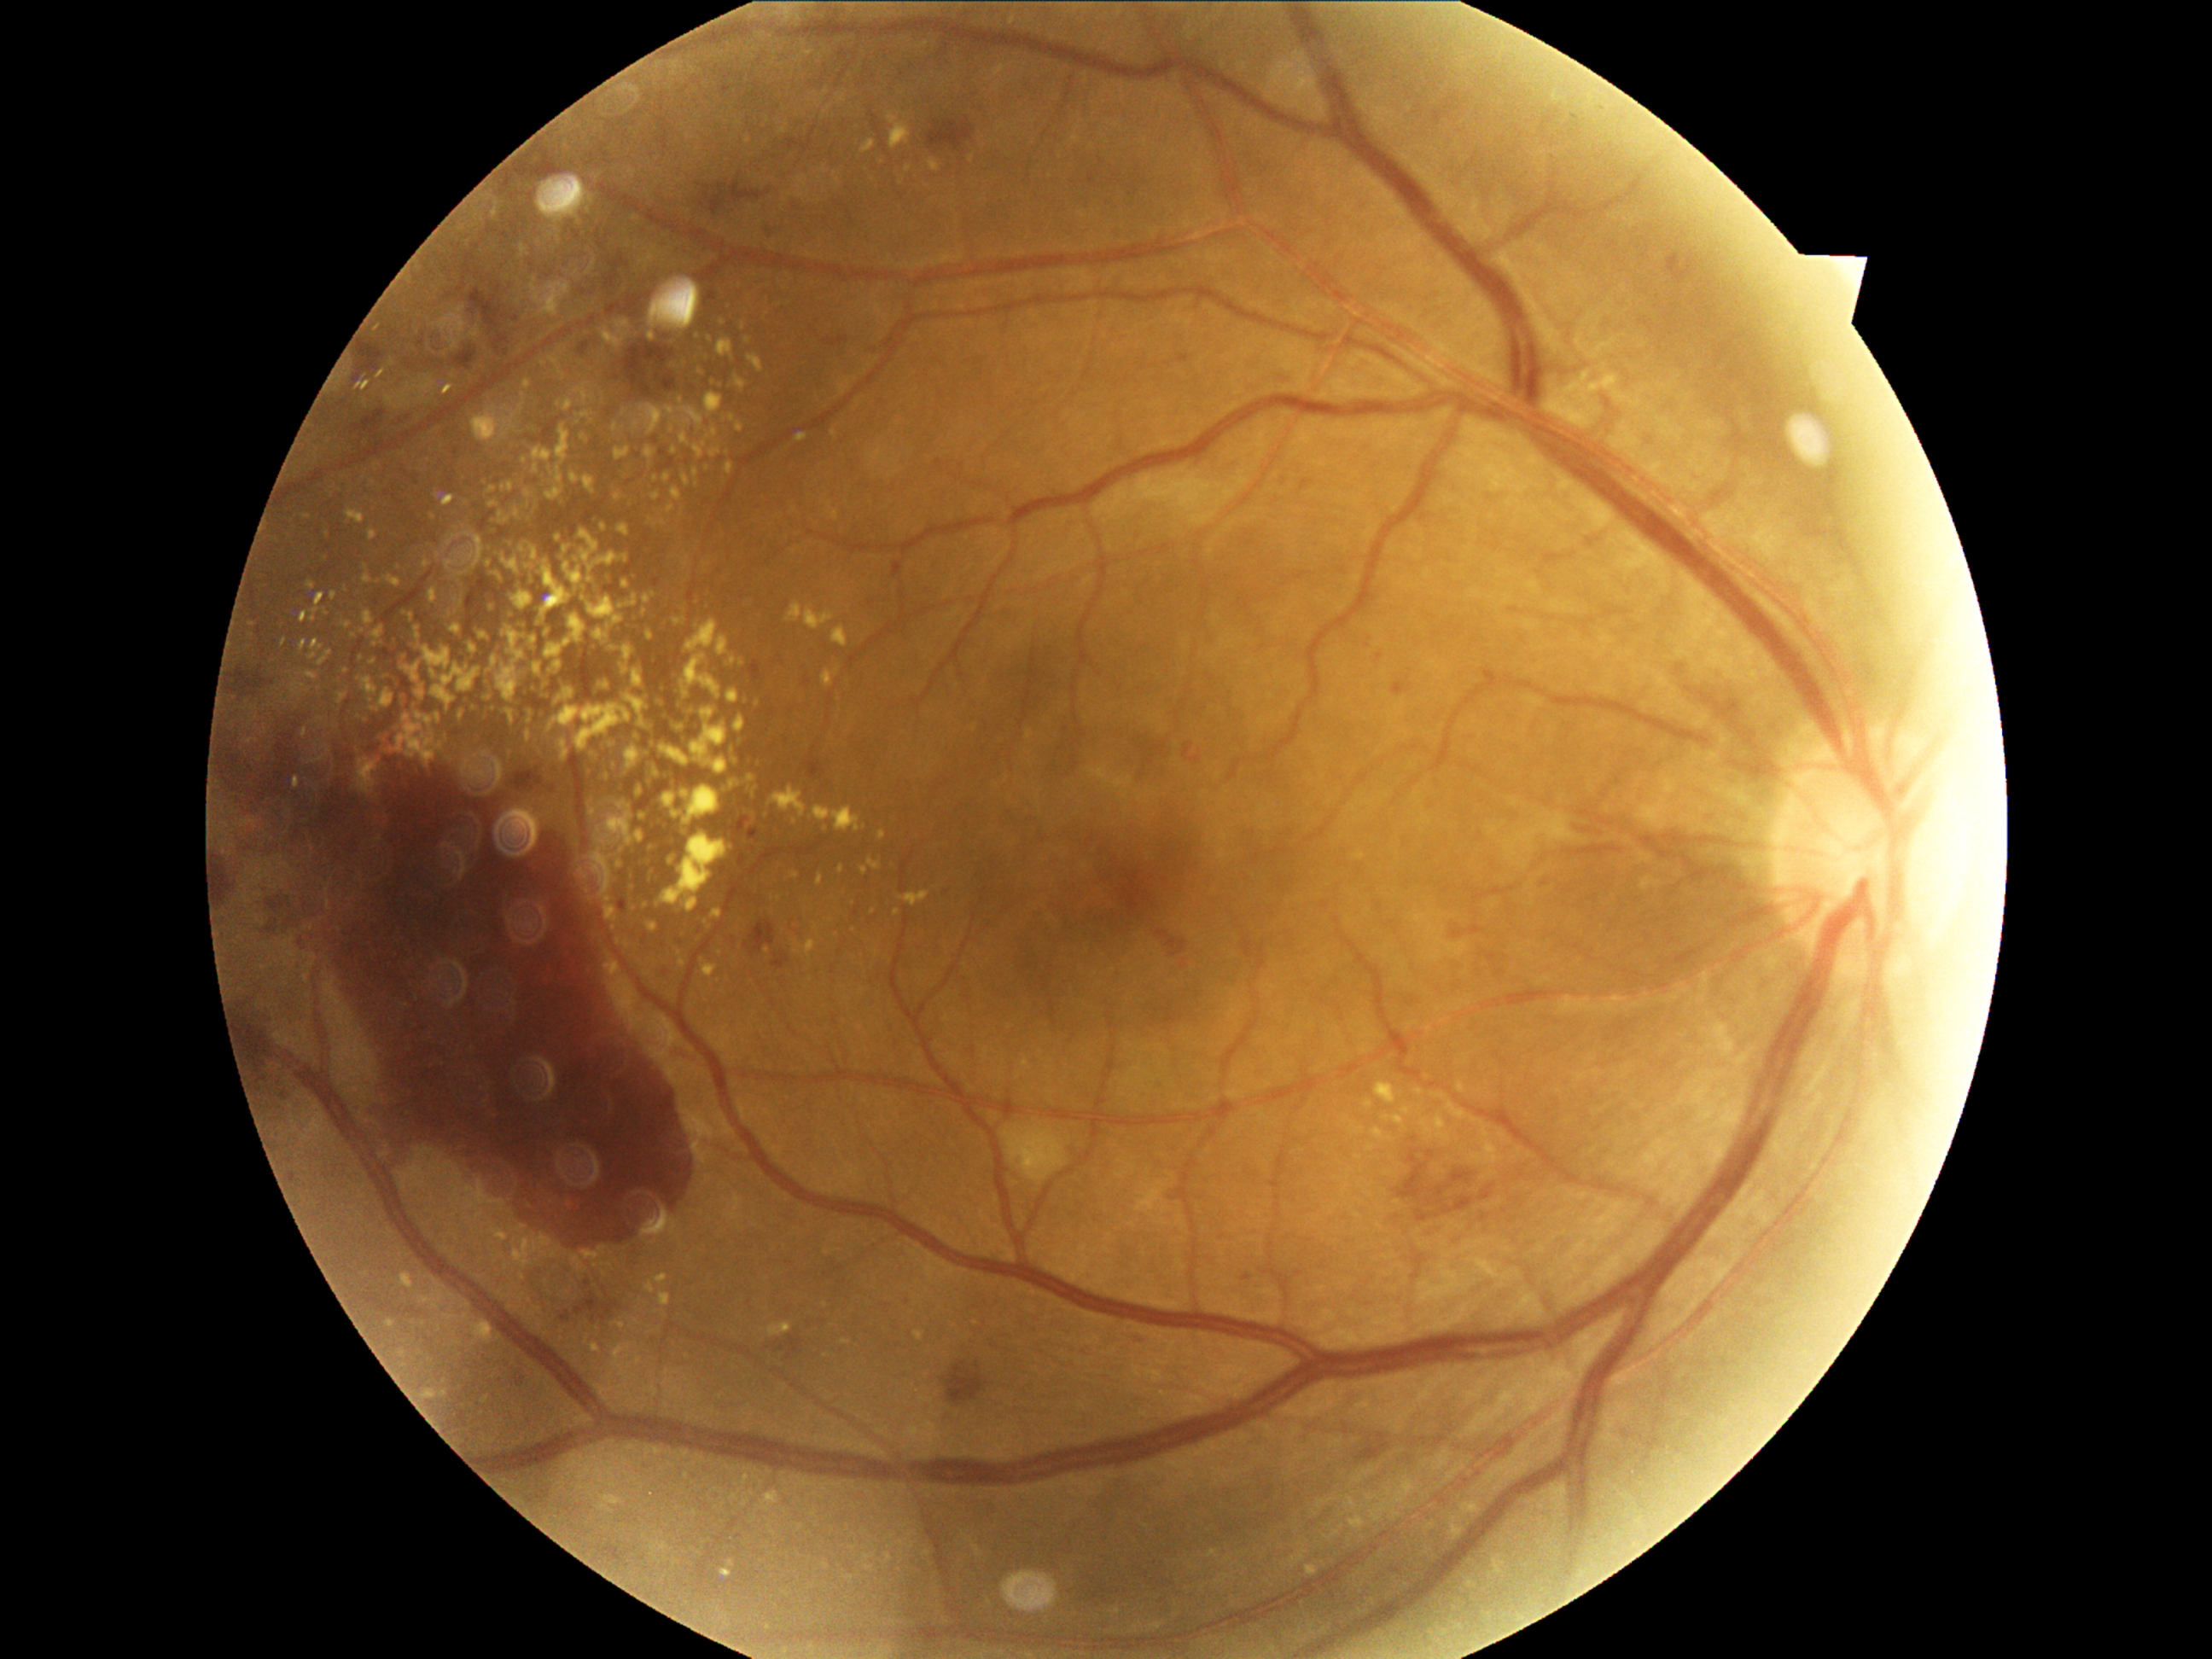 Diabetic retinopathy (DR): proliferative diabetic retinopathy (grade 4)
Lesions identified (partial list):
• hard exudates (EXs) (partial): x1=603 y1=330 x2=622 y2=347 | x1=868 y1=861 x2=880 y2=870 | x1=646 y1=704 x2=651 y2=713 | x1=545 y1=489 x2=564 y2=501 | x1=482 y1=667 x2=492 y2=672 | x1=569 y1=615 x2=586 y2=648 | x1=530 y1=687 x2=538 y2=696 | x1=550 y1=1249 x2=562 y2=1259 | x1=1557 y1=373 x2=1624 y2=402 | x1=706 y1=463 x2=709 y2=474 | x1=605 y1=738 x2=612 y2=747 | x1=619 y1=663 x2=626 y2=673 | x1=725 y1=781 x2=740 y2=791
• Additional small EXs near {"x": 473, "y": 709} | {"x": 507, "y": 652} | {"x": 619, "y": 942} | {"x": 446, "y": 738} | {"x": 529, "y": 586} | {"x": 656, "y": 497}